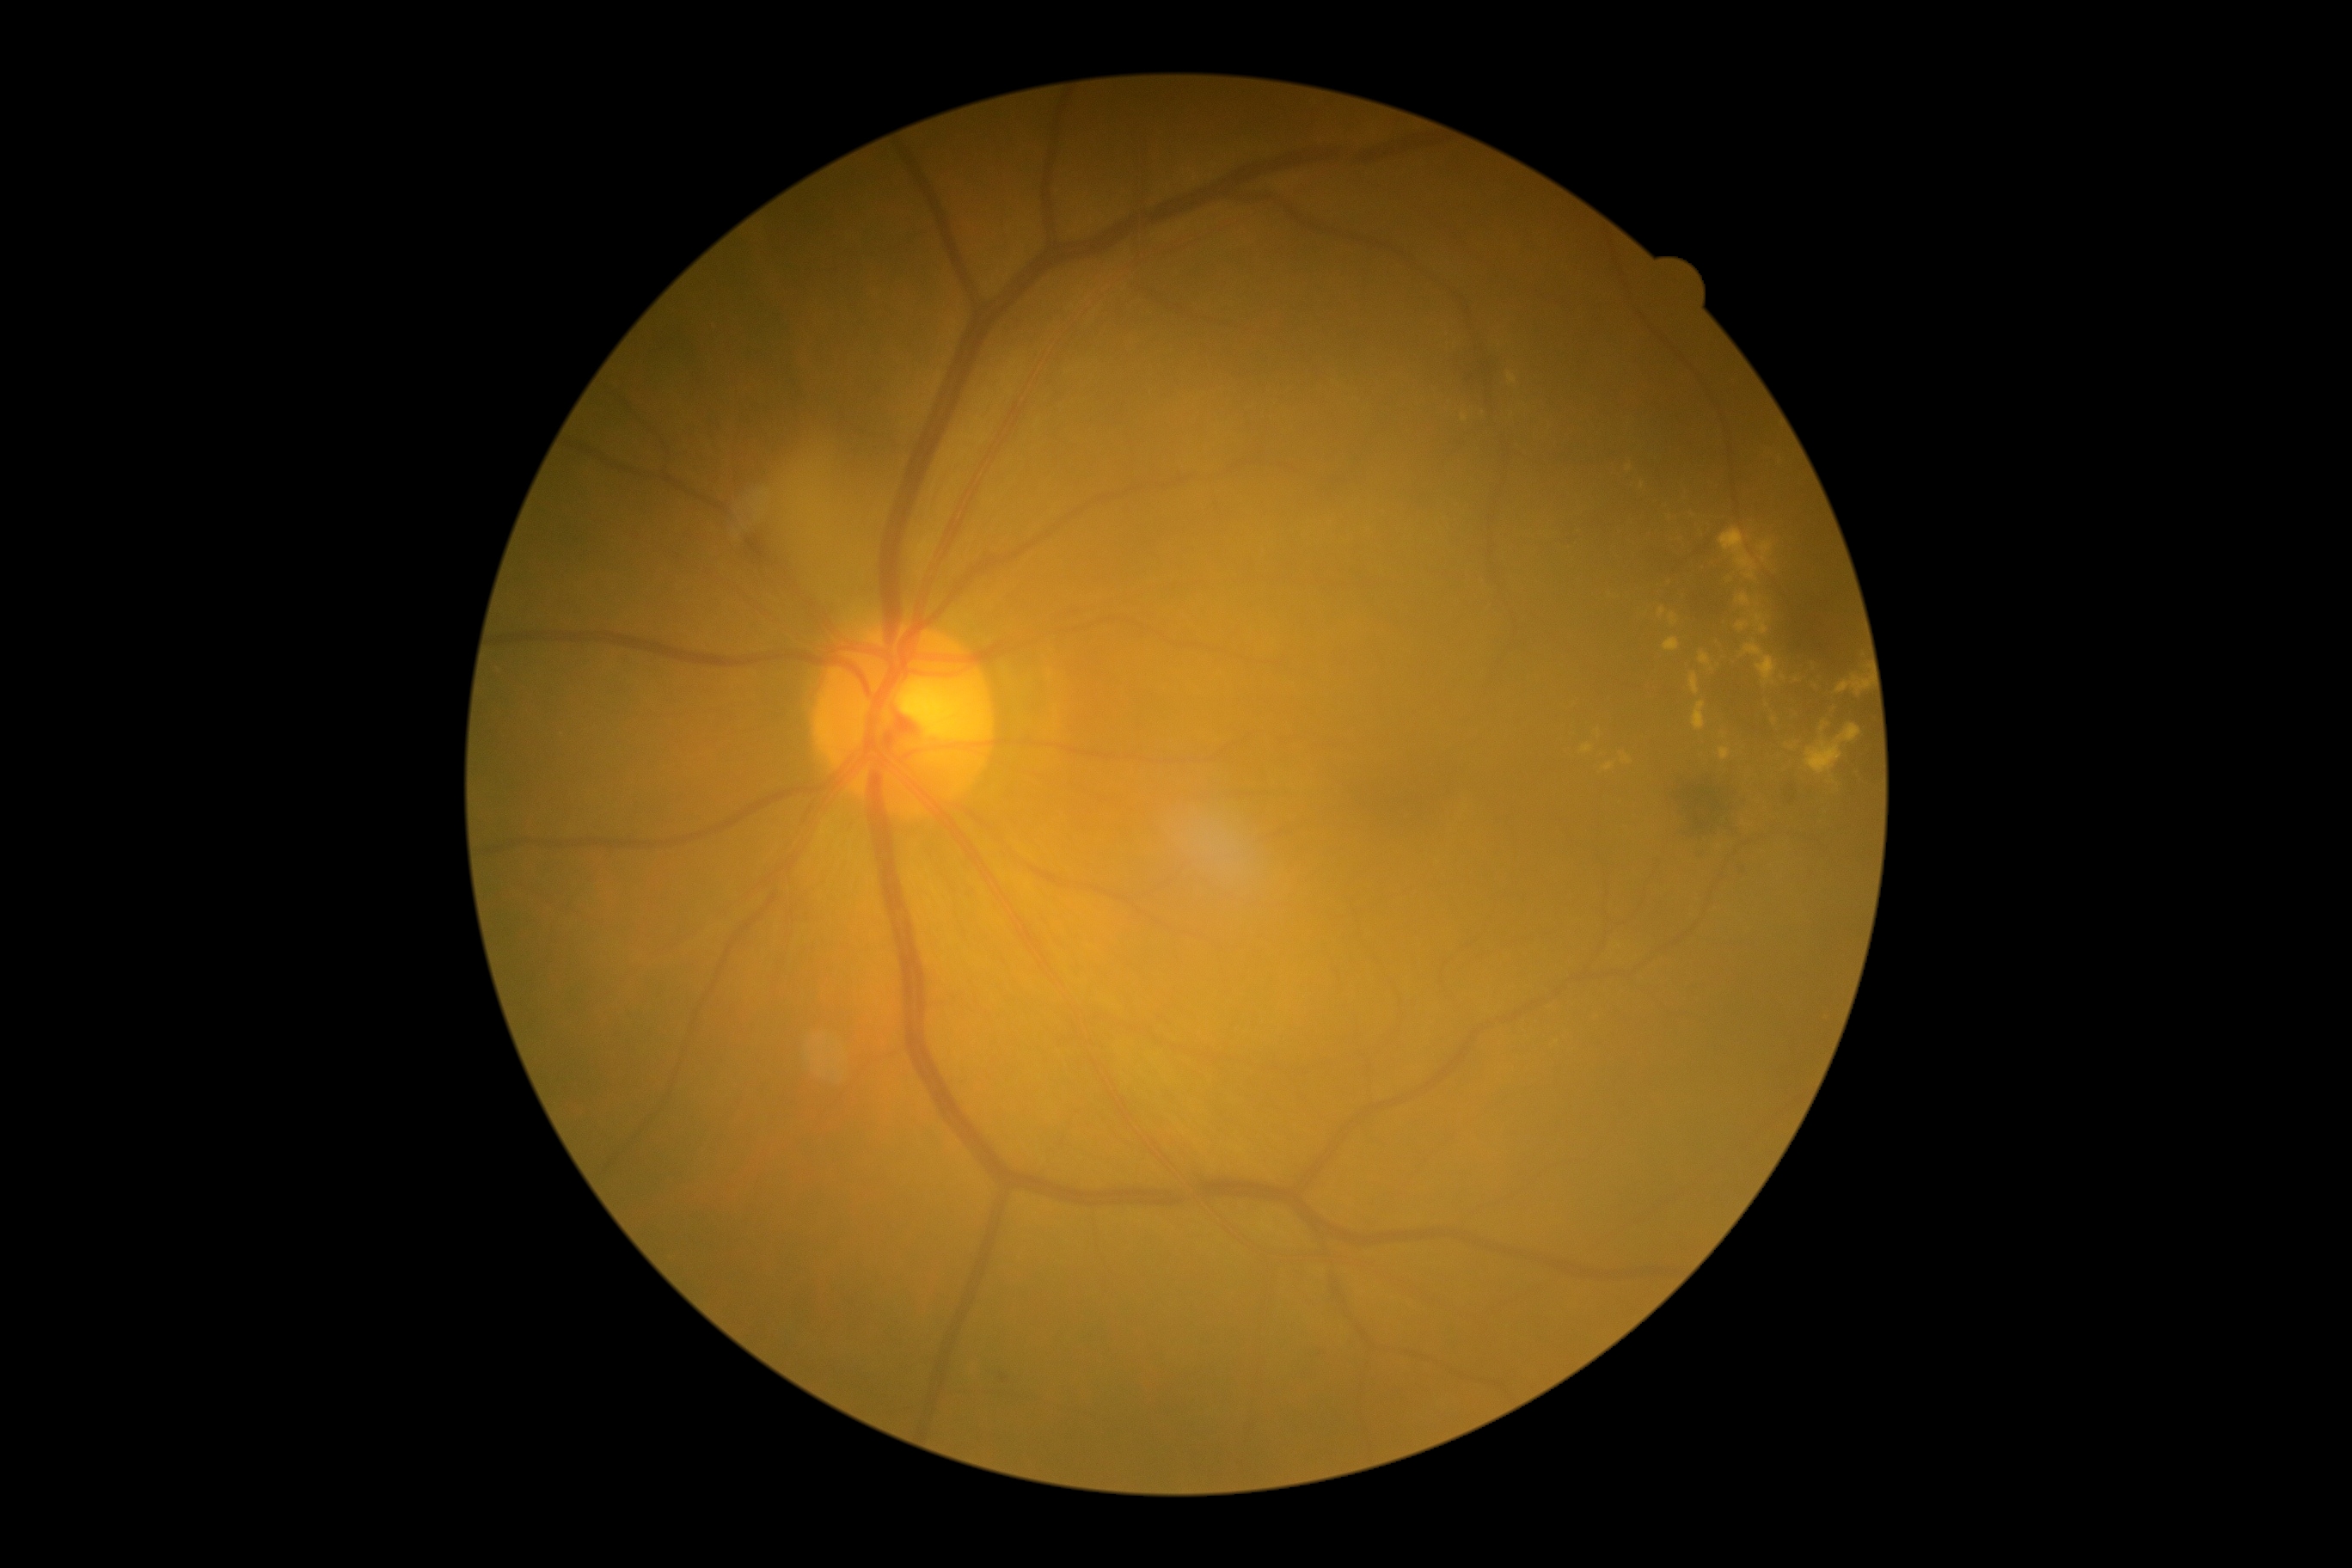
DR class: non-proliferative diabetic retinopathy
retinopathy grade: 2